Davis DR grading, posterior pole photograph, 45° field of view, 848 x 848 pixels: 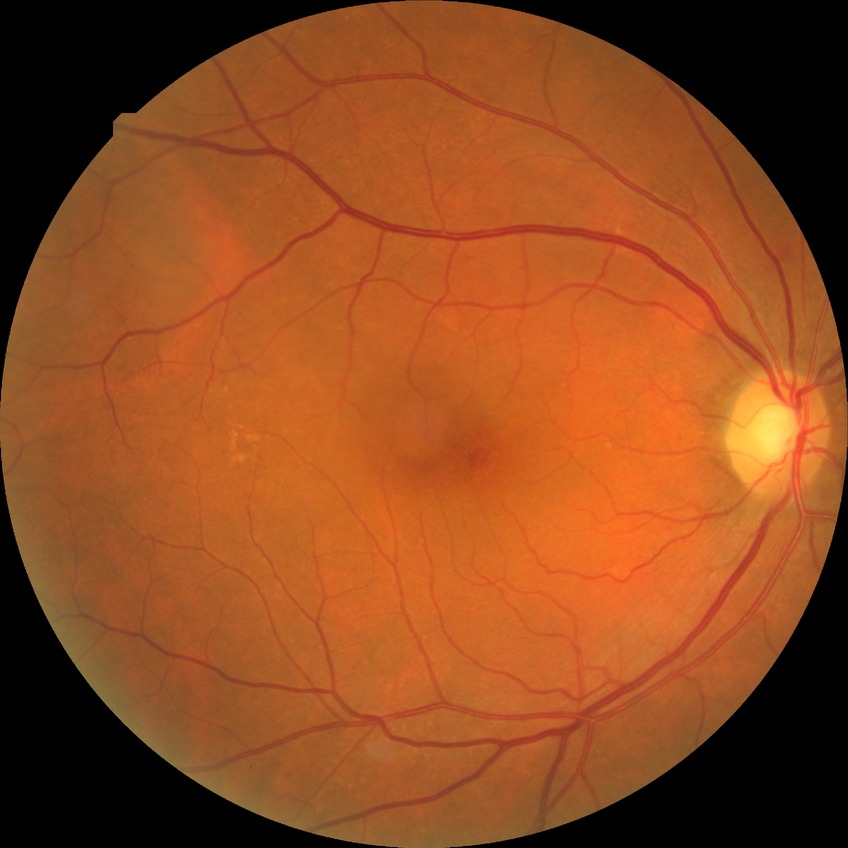 Diabetic retinopathy (DR) is NDR (no diabetic retinopathy).